Image size 1932x1932:
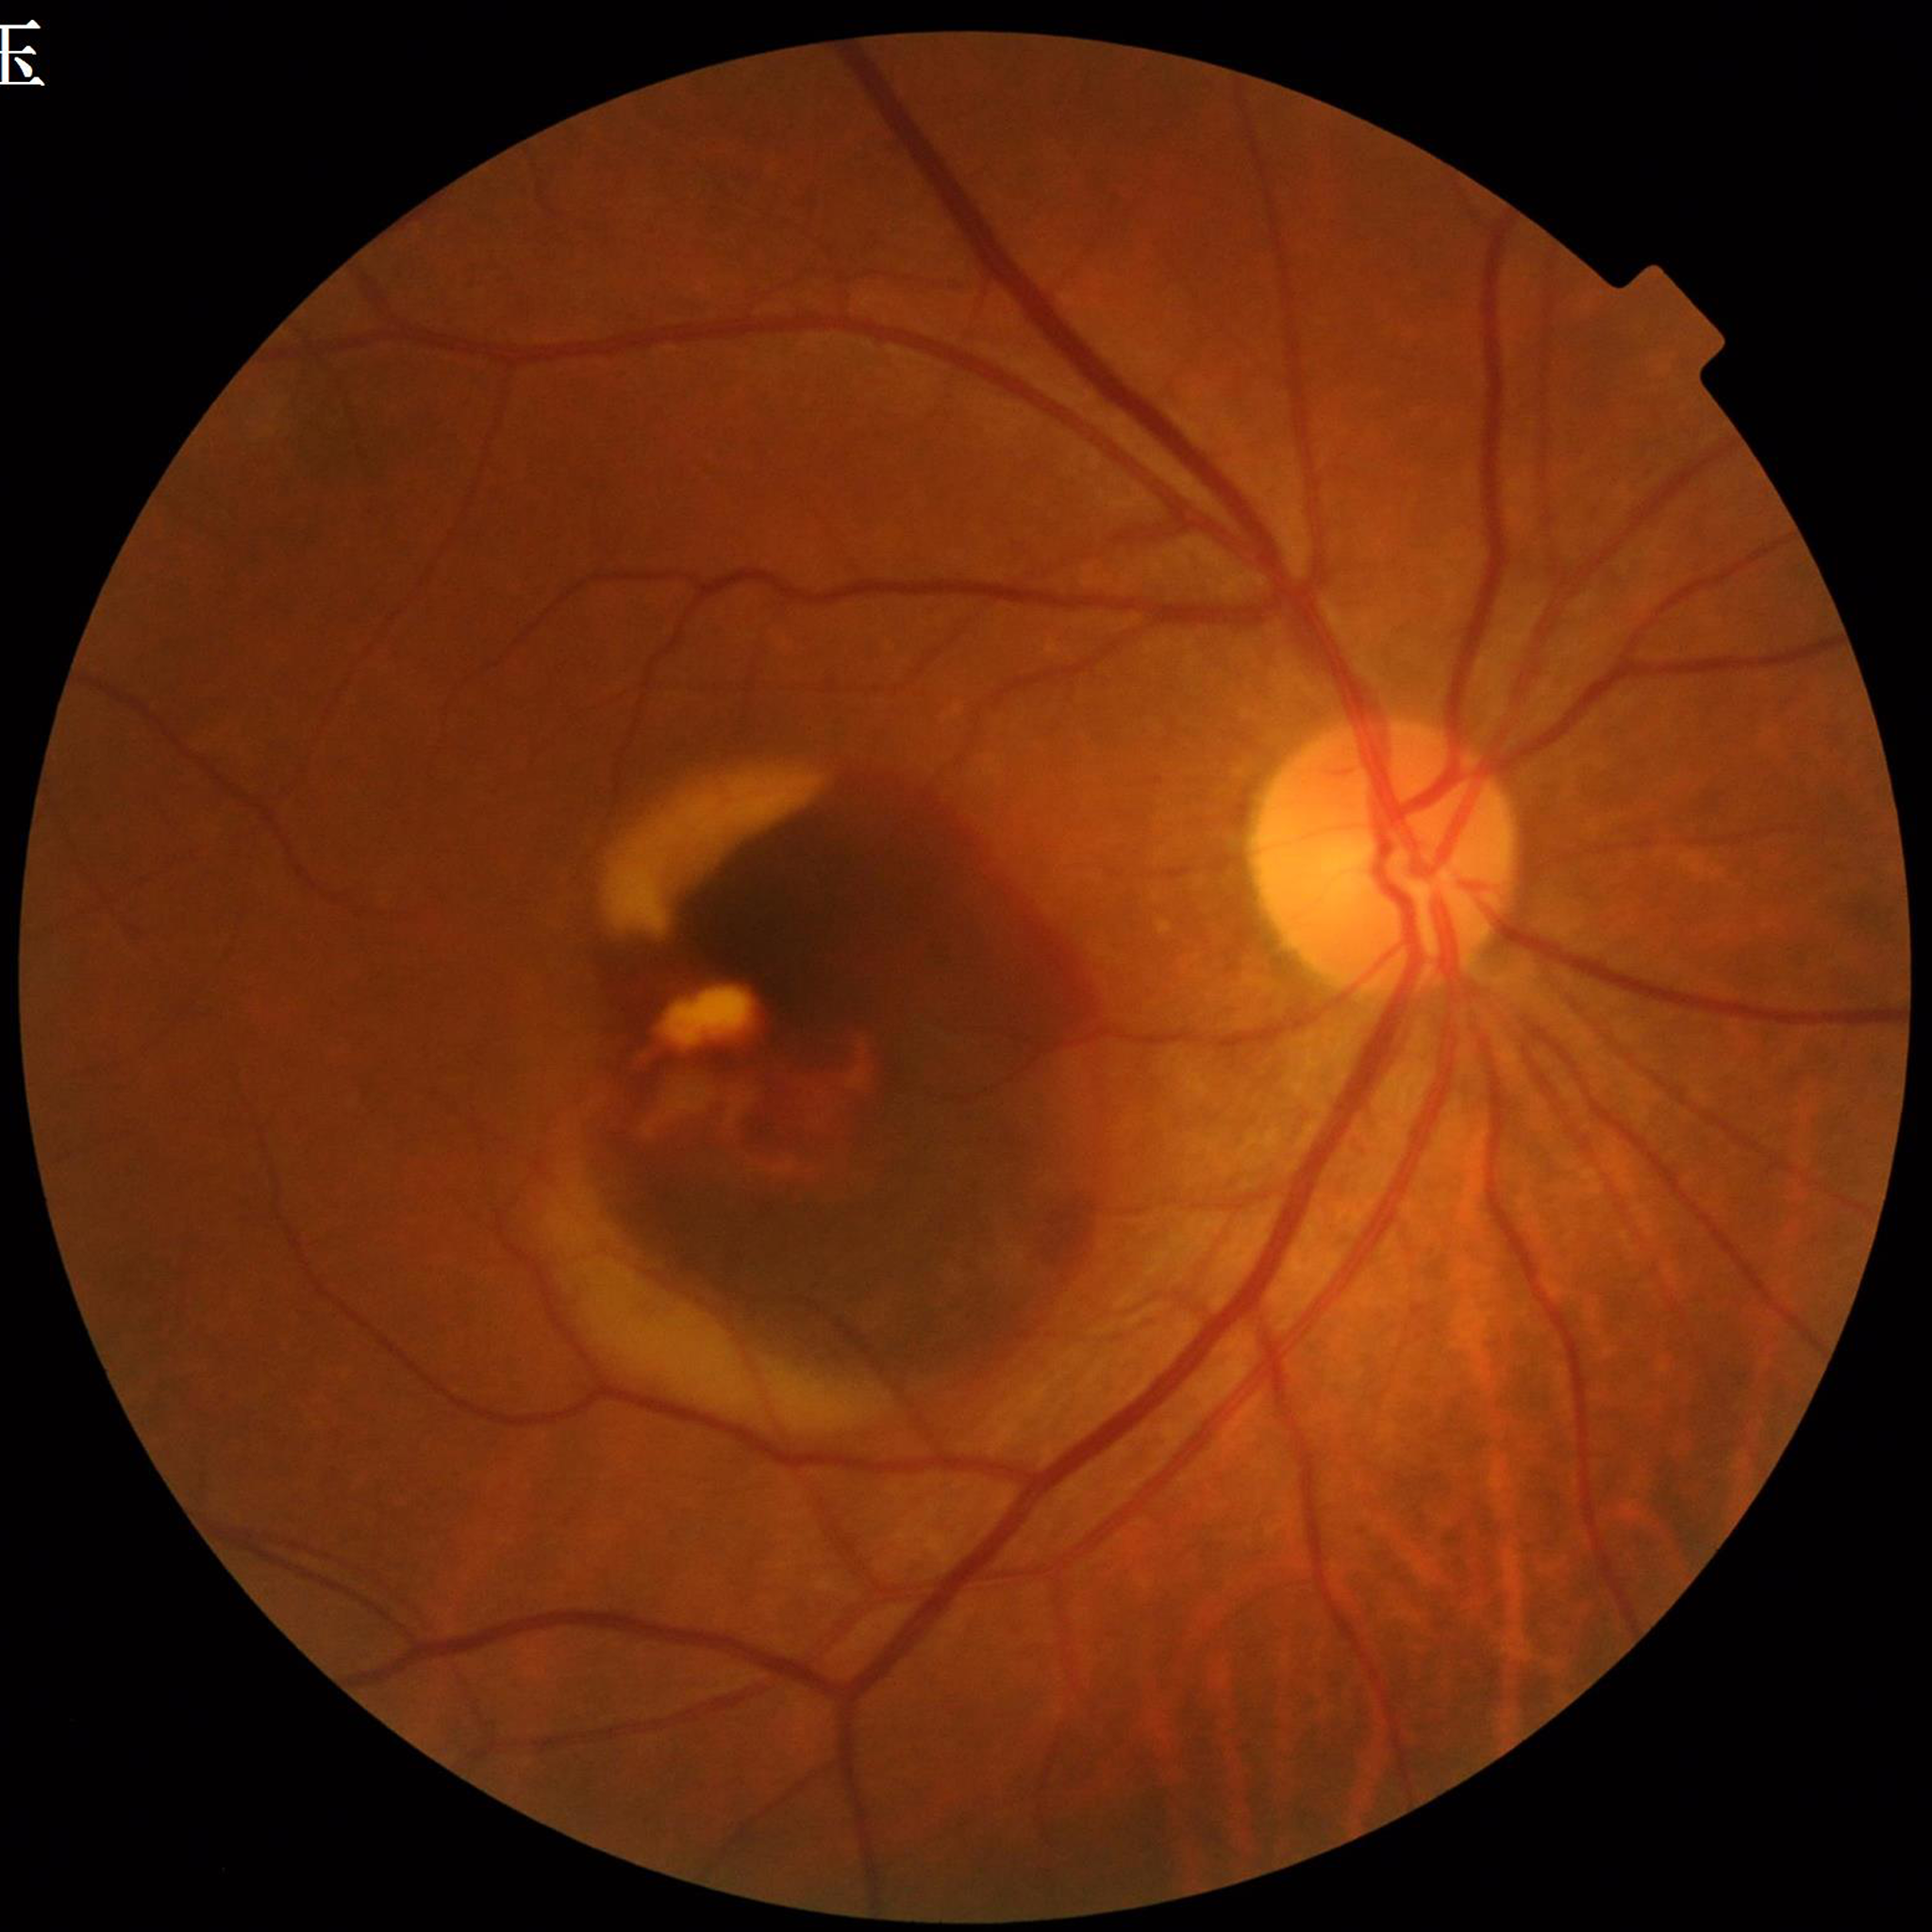

Diagnosed with age-related macular degeneration.
Quality: no quality issues identified.